Fundus photo.
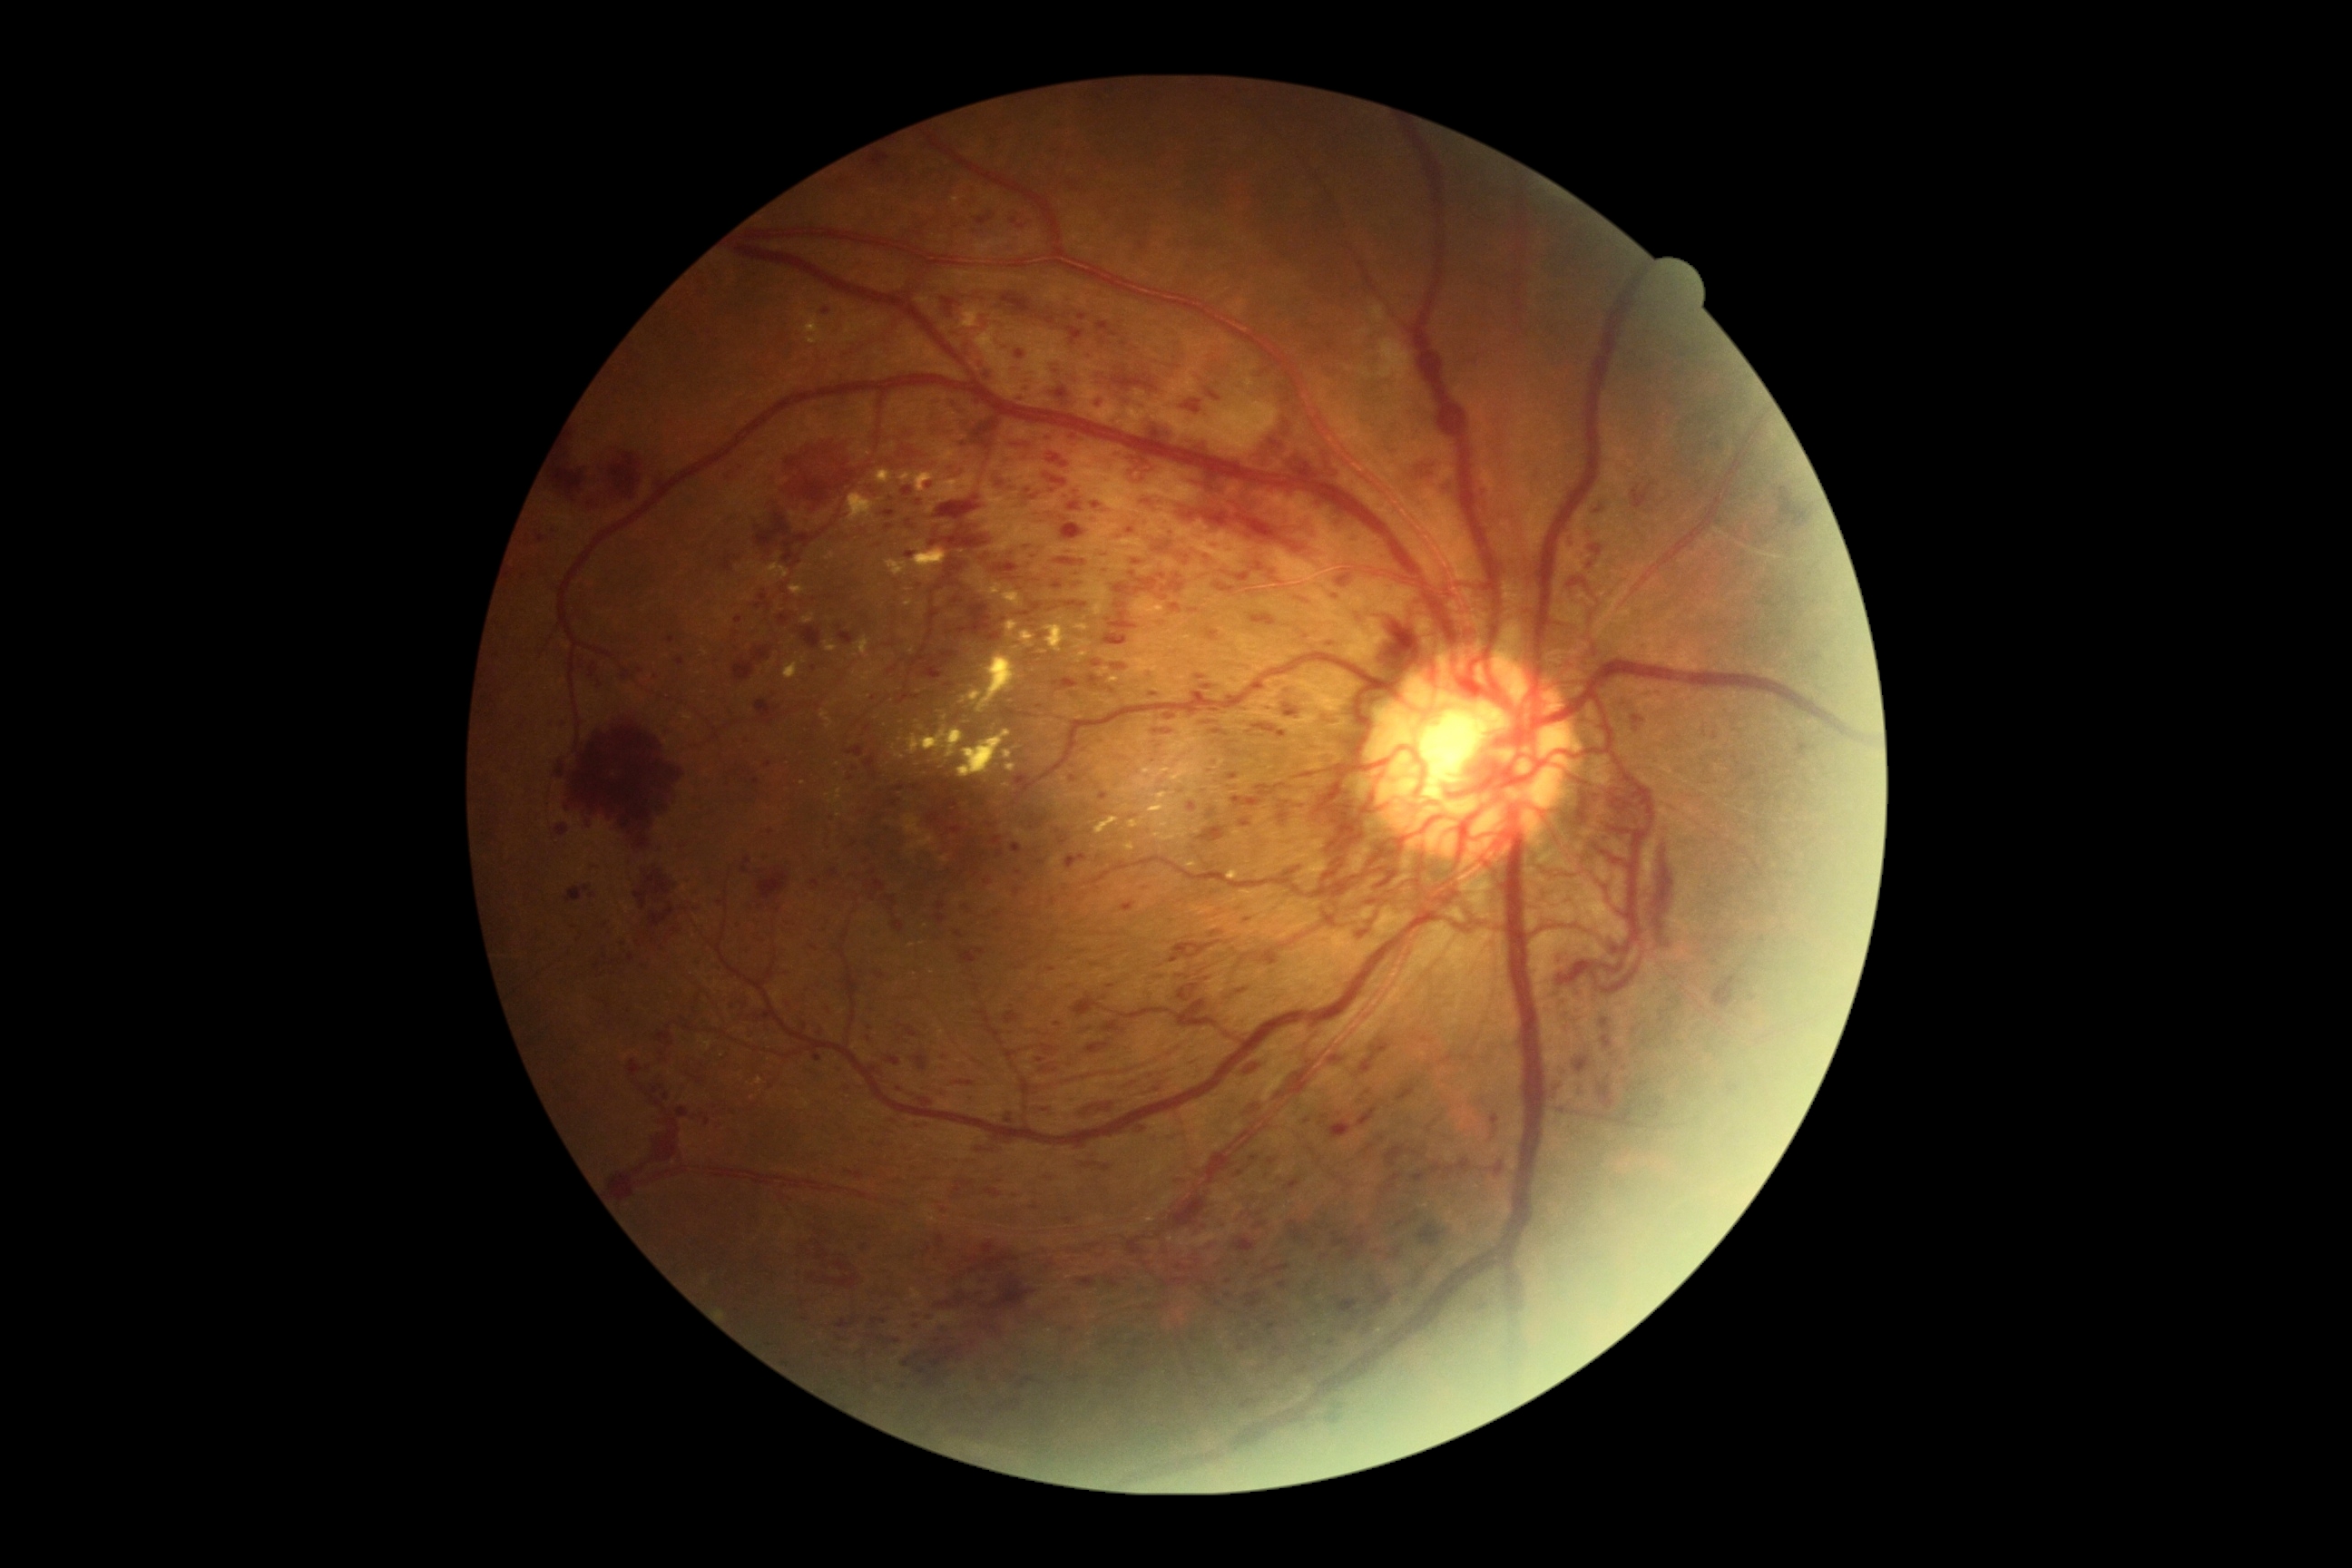 Diabetic retinopathy (DR) is grade 4 (PDR) — neovascularization and/or vitreous/pre-retinal hemorrhage
Representative lesions:
hemorrhages (HEs) (more not shown): left=1075, top=1277, right=1097, bottom=1289, left=1286, top=1179, right=1300, bottom=1191, left=1231, top=798, right=1262, bottom=810, left=1133, top=560, right=1142, bottom=567, left=985, top=1326, right=999, bottom=1335, left=732, top=647, right=774, bottom=681, left=1333, top=1233, right=1367, bottom=1262, left=1197, top=825, right=1228, bottom=845, left=1054, top=680, right=1079, bottom=692, left=1004, top=1113, right=1014, bottom=1124, left=1188, top=803, right=1197, bottom=812, left=1396, top=1081, right=1418, bottom=1102, left=1063, top=602, right=1088, bottom=611, left=631, top=865, right=691, bottom=934, left=1591, top=545, right=1603, bottom=558
HEs (small, approximate centers) near pt(1663, 1033), pt(805, 1319), pt(975, 1061), pt(1032, 621)
microaneurysms (MAs) (more not shown): left=1271, top=1355, right=1280, bottom=1366, left=1139, top=244, right=1148, bottom=251, left=594, top=961, right=602, bottom=972, left=692, top=906, right=700, bottom=912, left=983, top=554, right=992, bottom=562, left=823, top=309, right=832, bottom=315, left=1043, top=364, right=1055, bottom=377, left=1264, top=1322, right=1277, bottom=1331
MAs (small, approximate centers) near pt(1308, 1122), pt(933, 1314), pt(1040, 1061), pt(1229, 1296), pt(1026, 548), pt(1052, 970), pt(1020, 354), pt(550, 722), pt(856, 768)